2184x1690px:
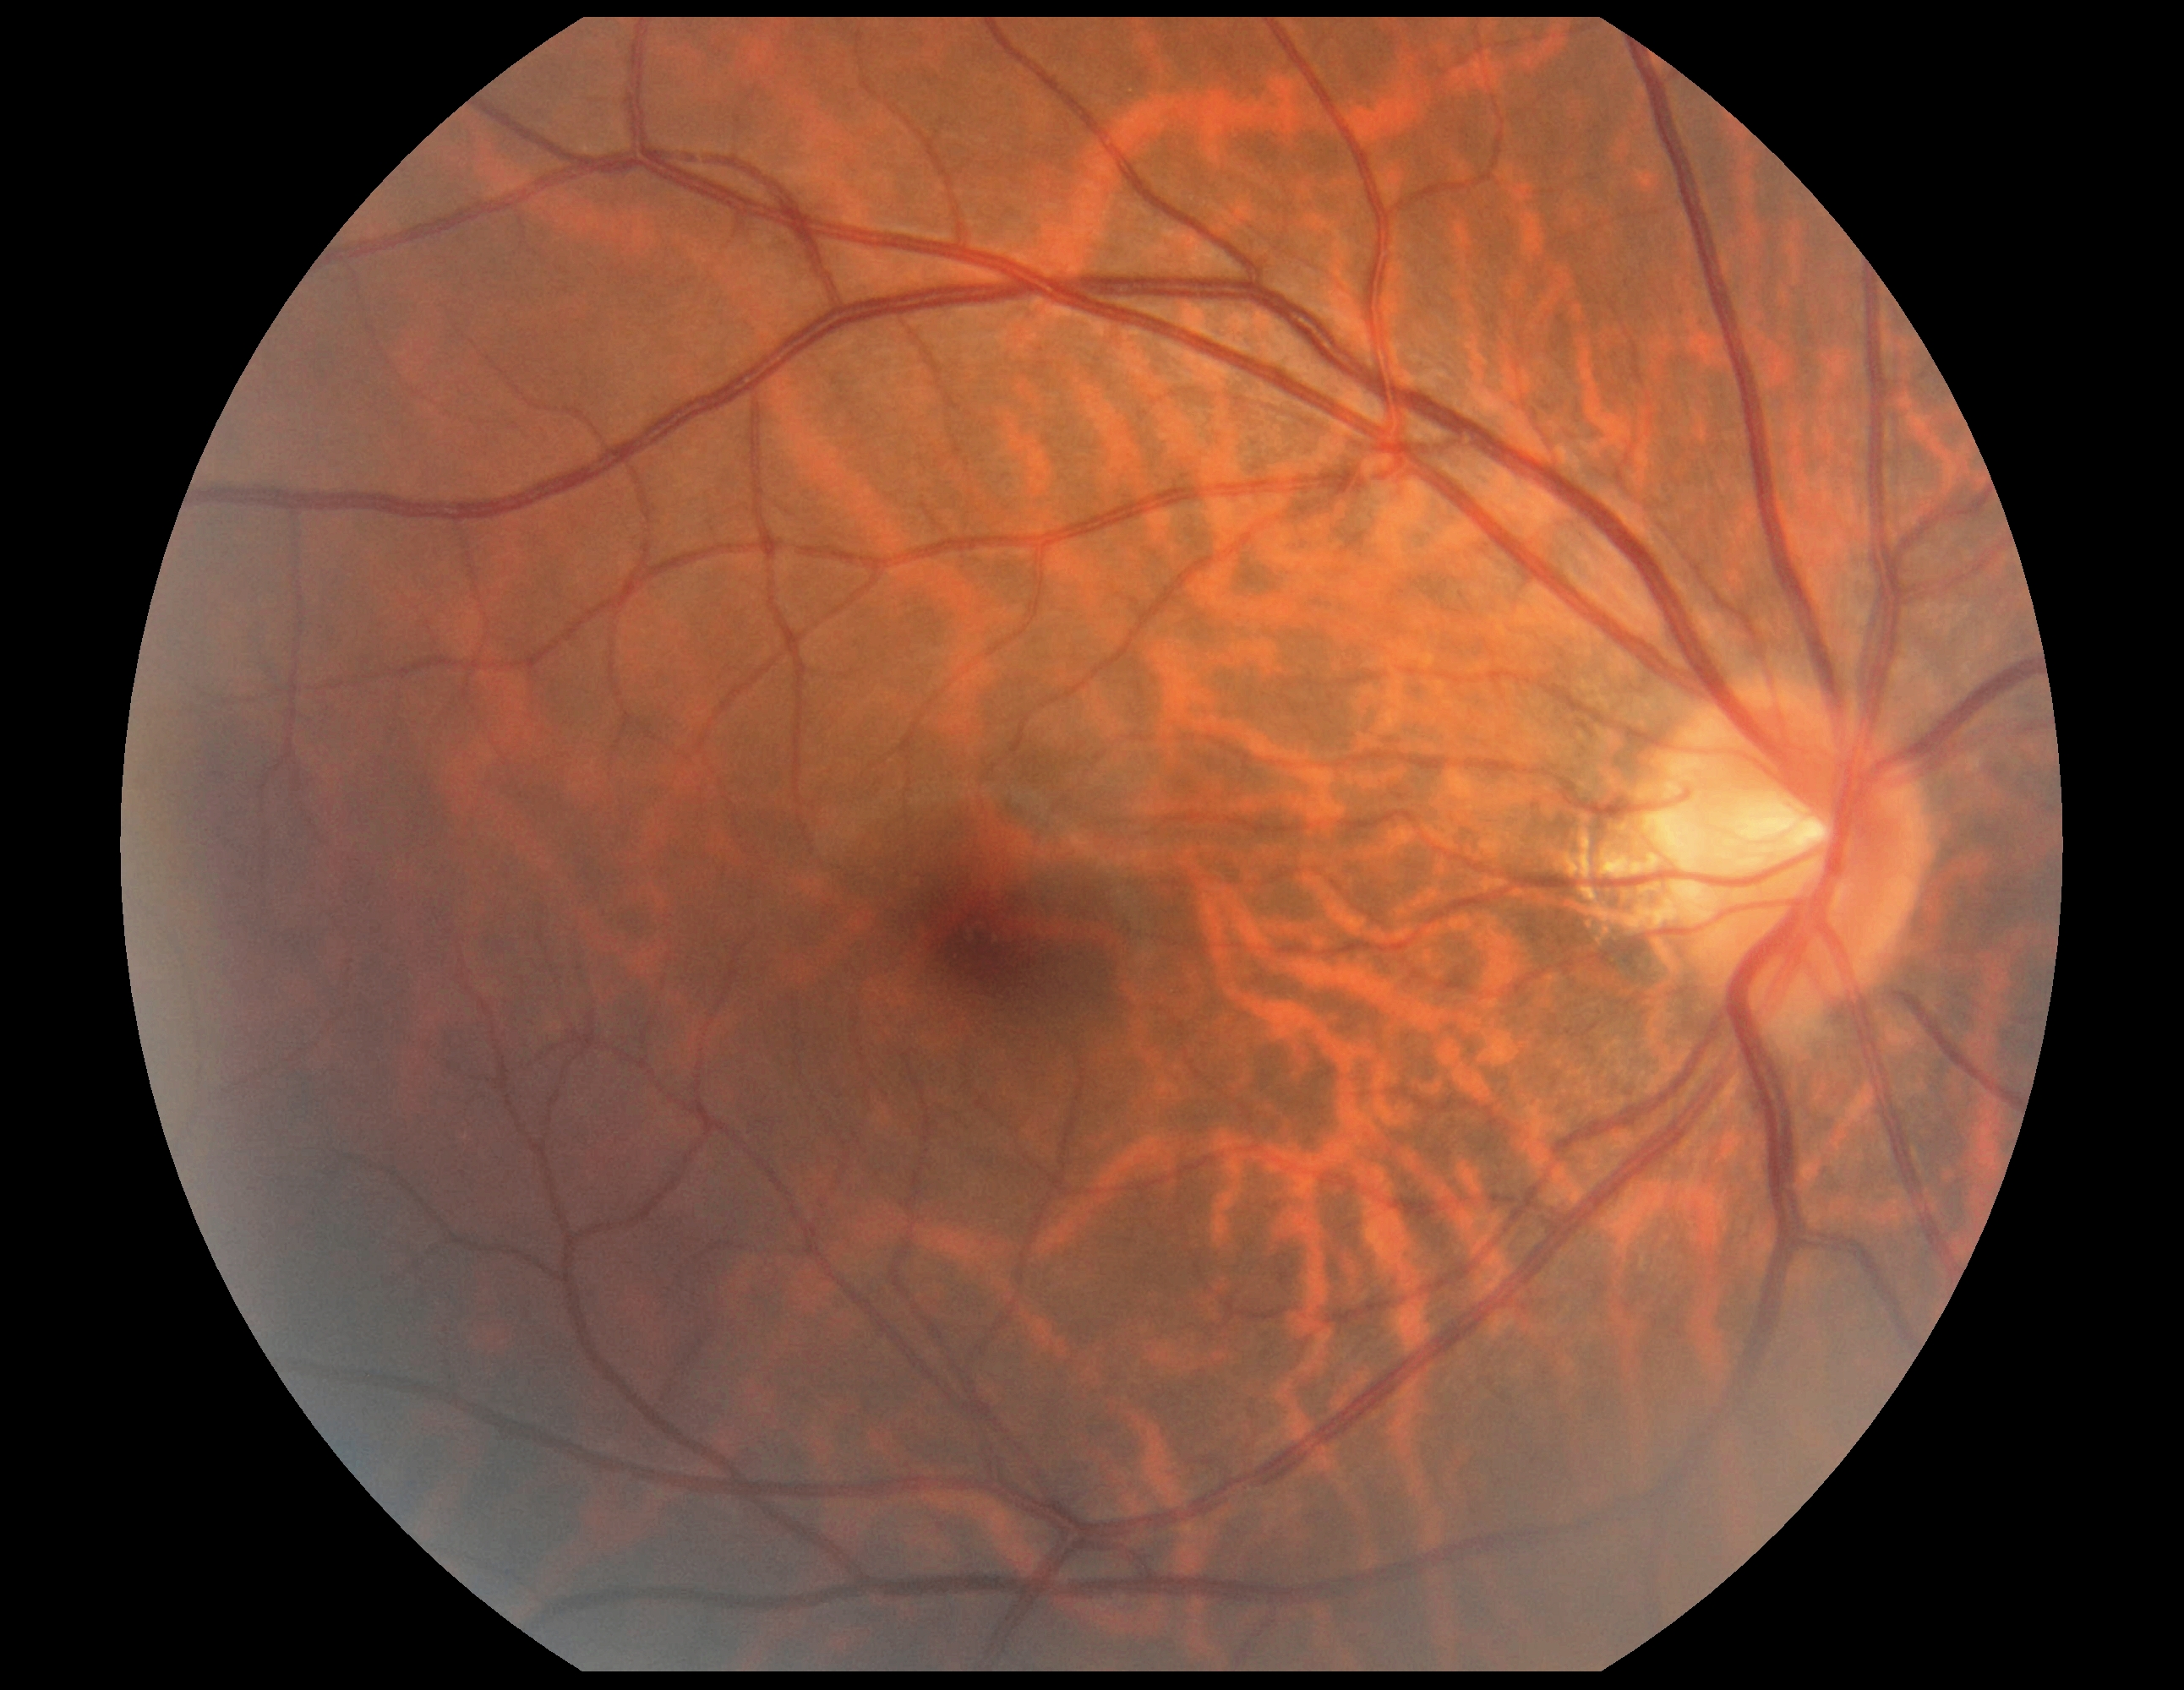

DR stage: no apparent diabetic retinopathy (grade 0).